Phoenix ICON wide-field infant fundus image. 100° field of view (Phoenix ICON). 1240x1240
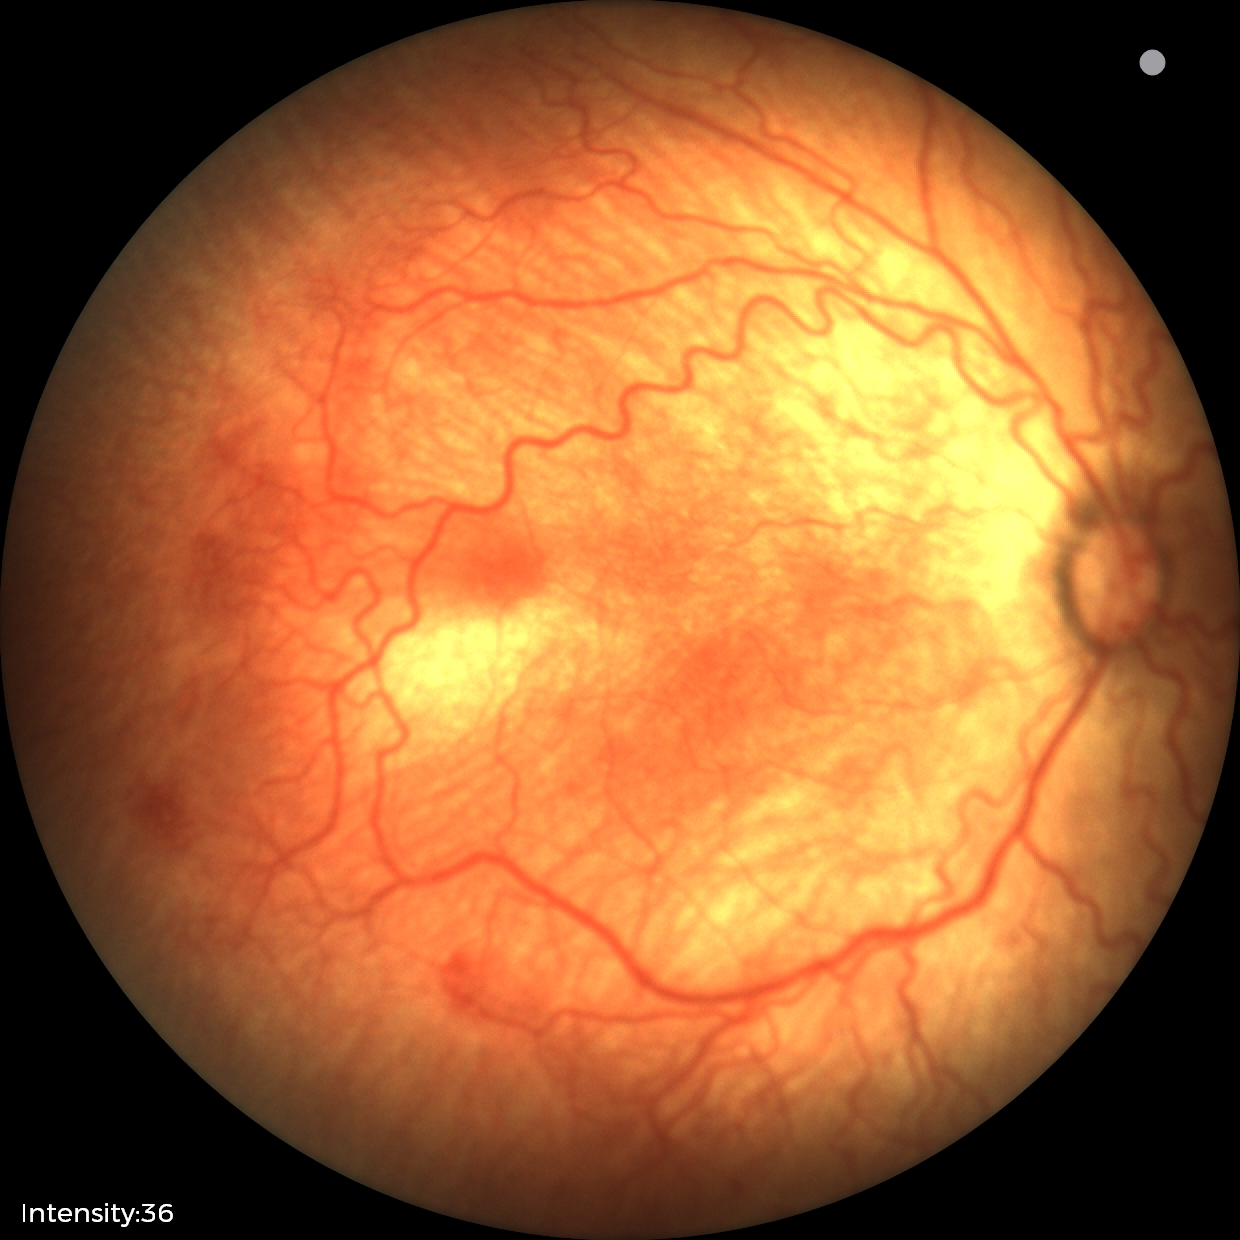

Q: What is the screening diagnosis?
A: retinopathy of prematurity stage 2
Q: Plus disease status?
A: plus disease